Graded on the modified Davis scale
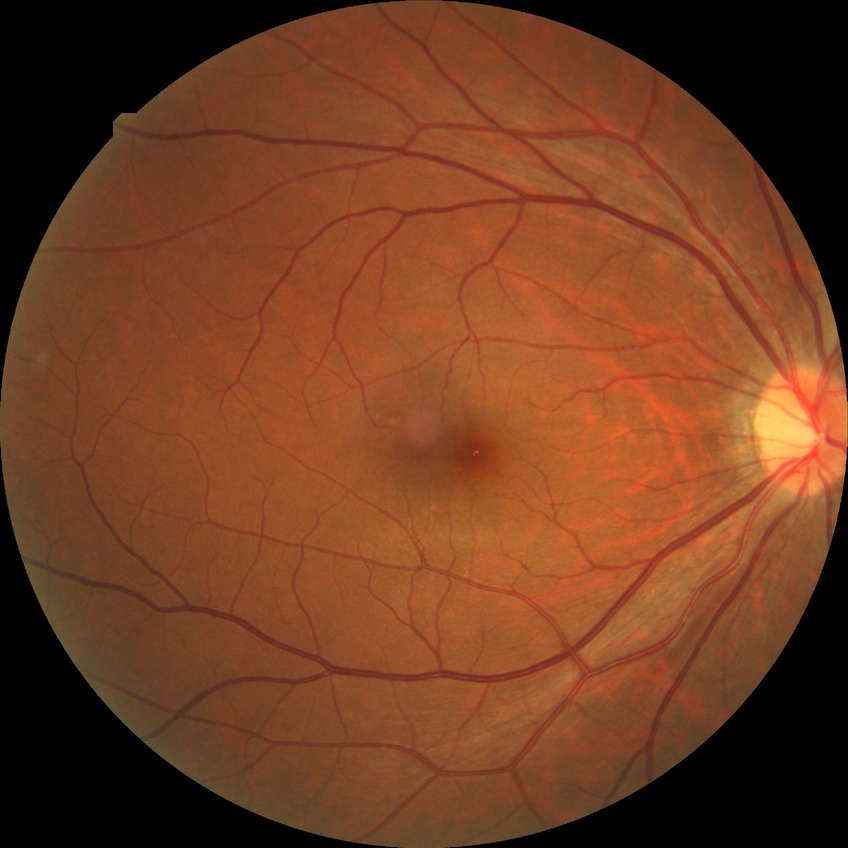

{
  "dr_impression": "negative for DR",
  "davis_grade": "NDR"
}